Diabetic retinopathy graded by the modified Davis classification, 45-degree field of view, NIDEK AFC-230 fundus camera — 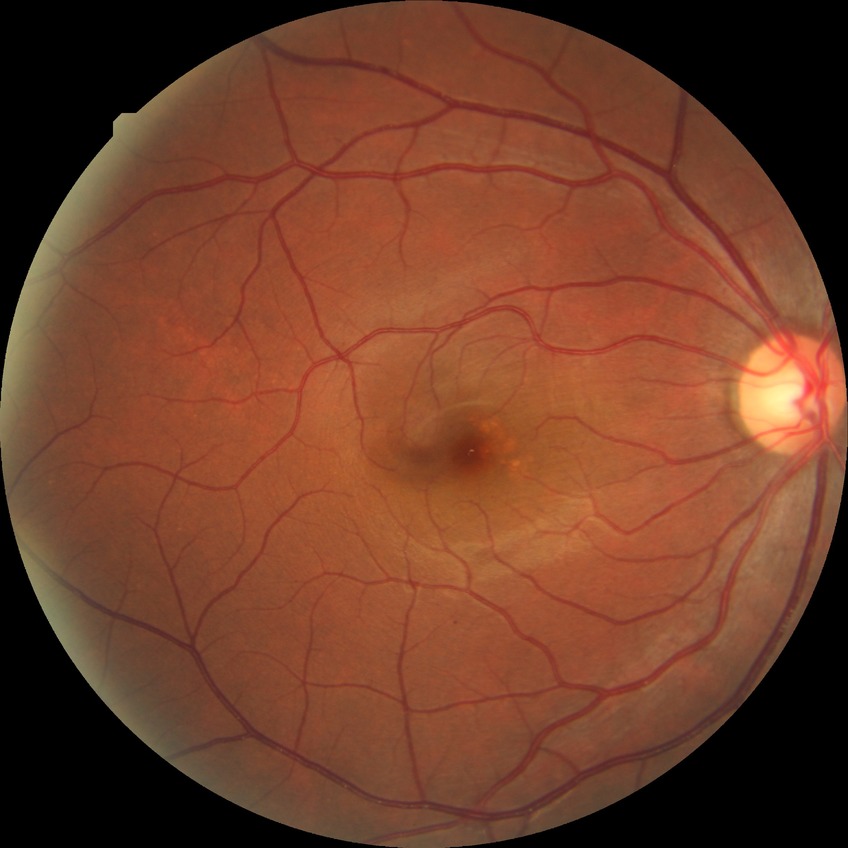
Diabetic retinopathy grade: simple diabetic retinopathy.